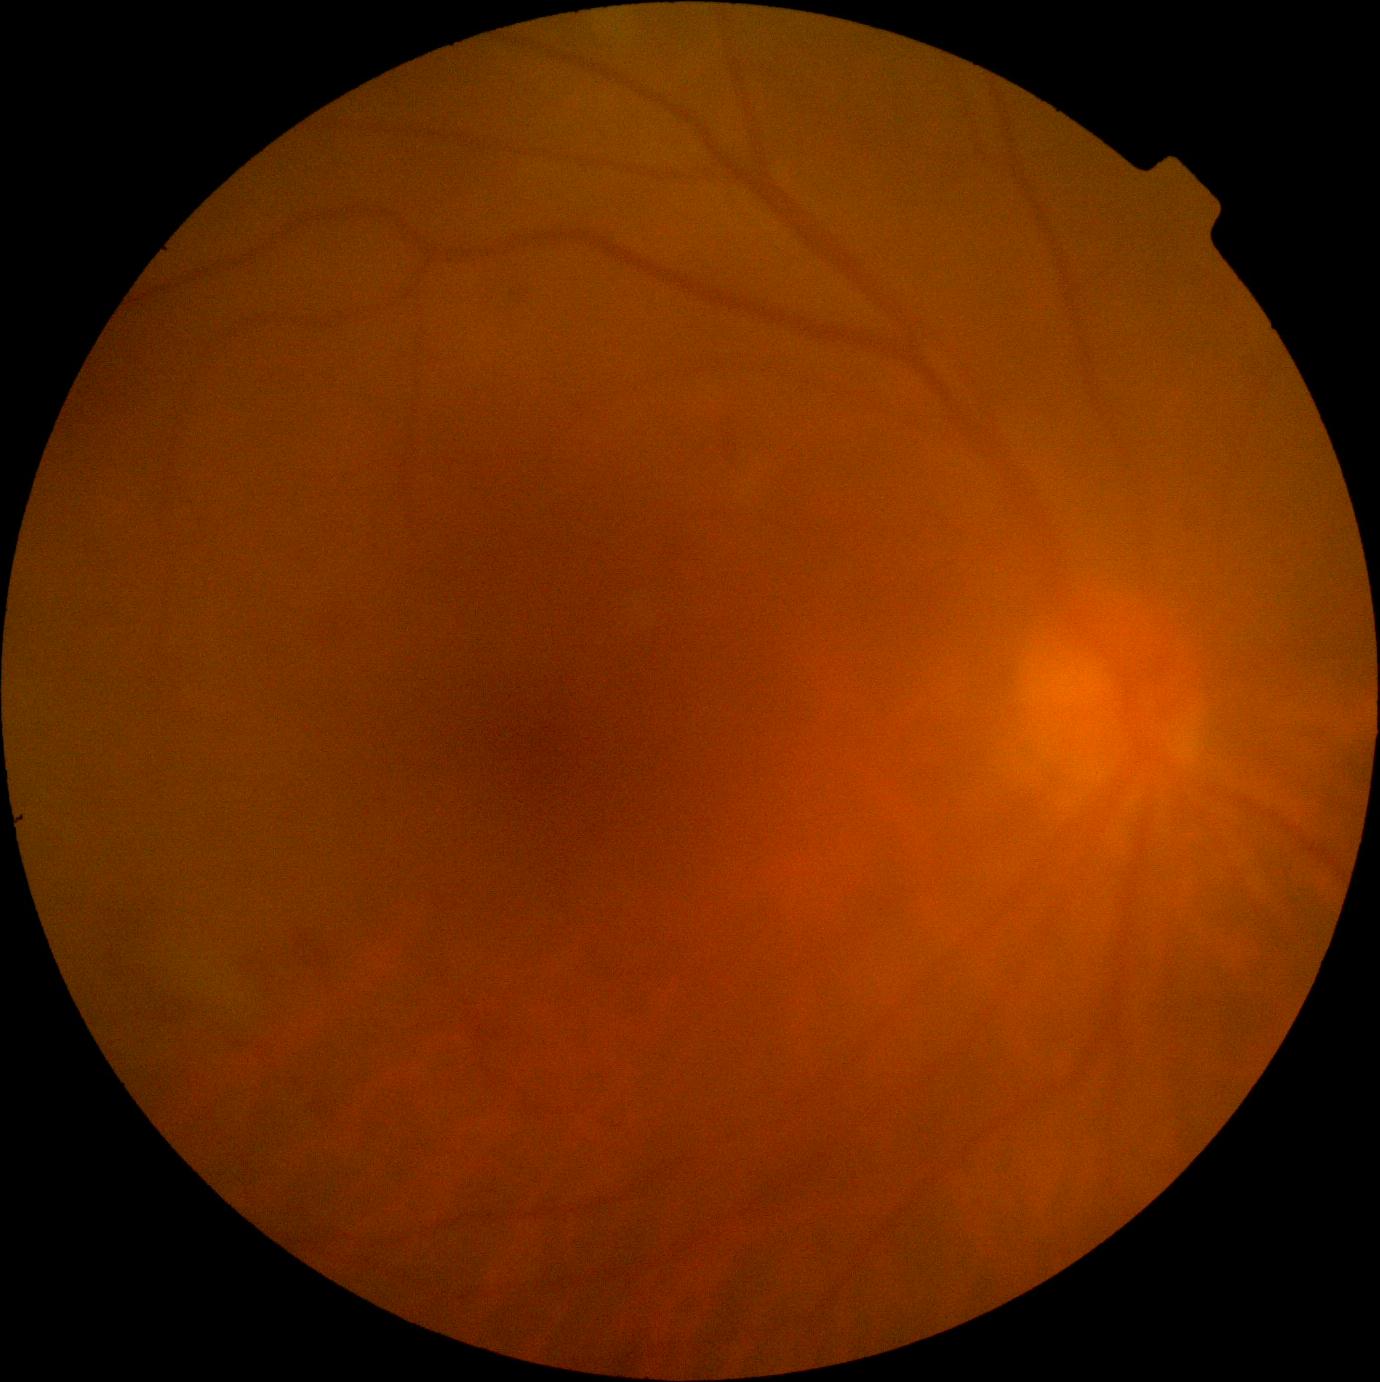 Diabetic retinopathy is grade 2 (moderate NPDR) — more than just microaneurysms but less than severe NPDR.